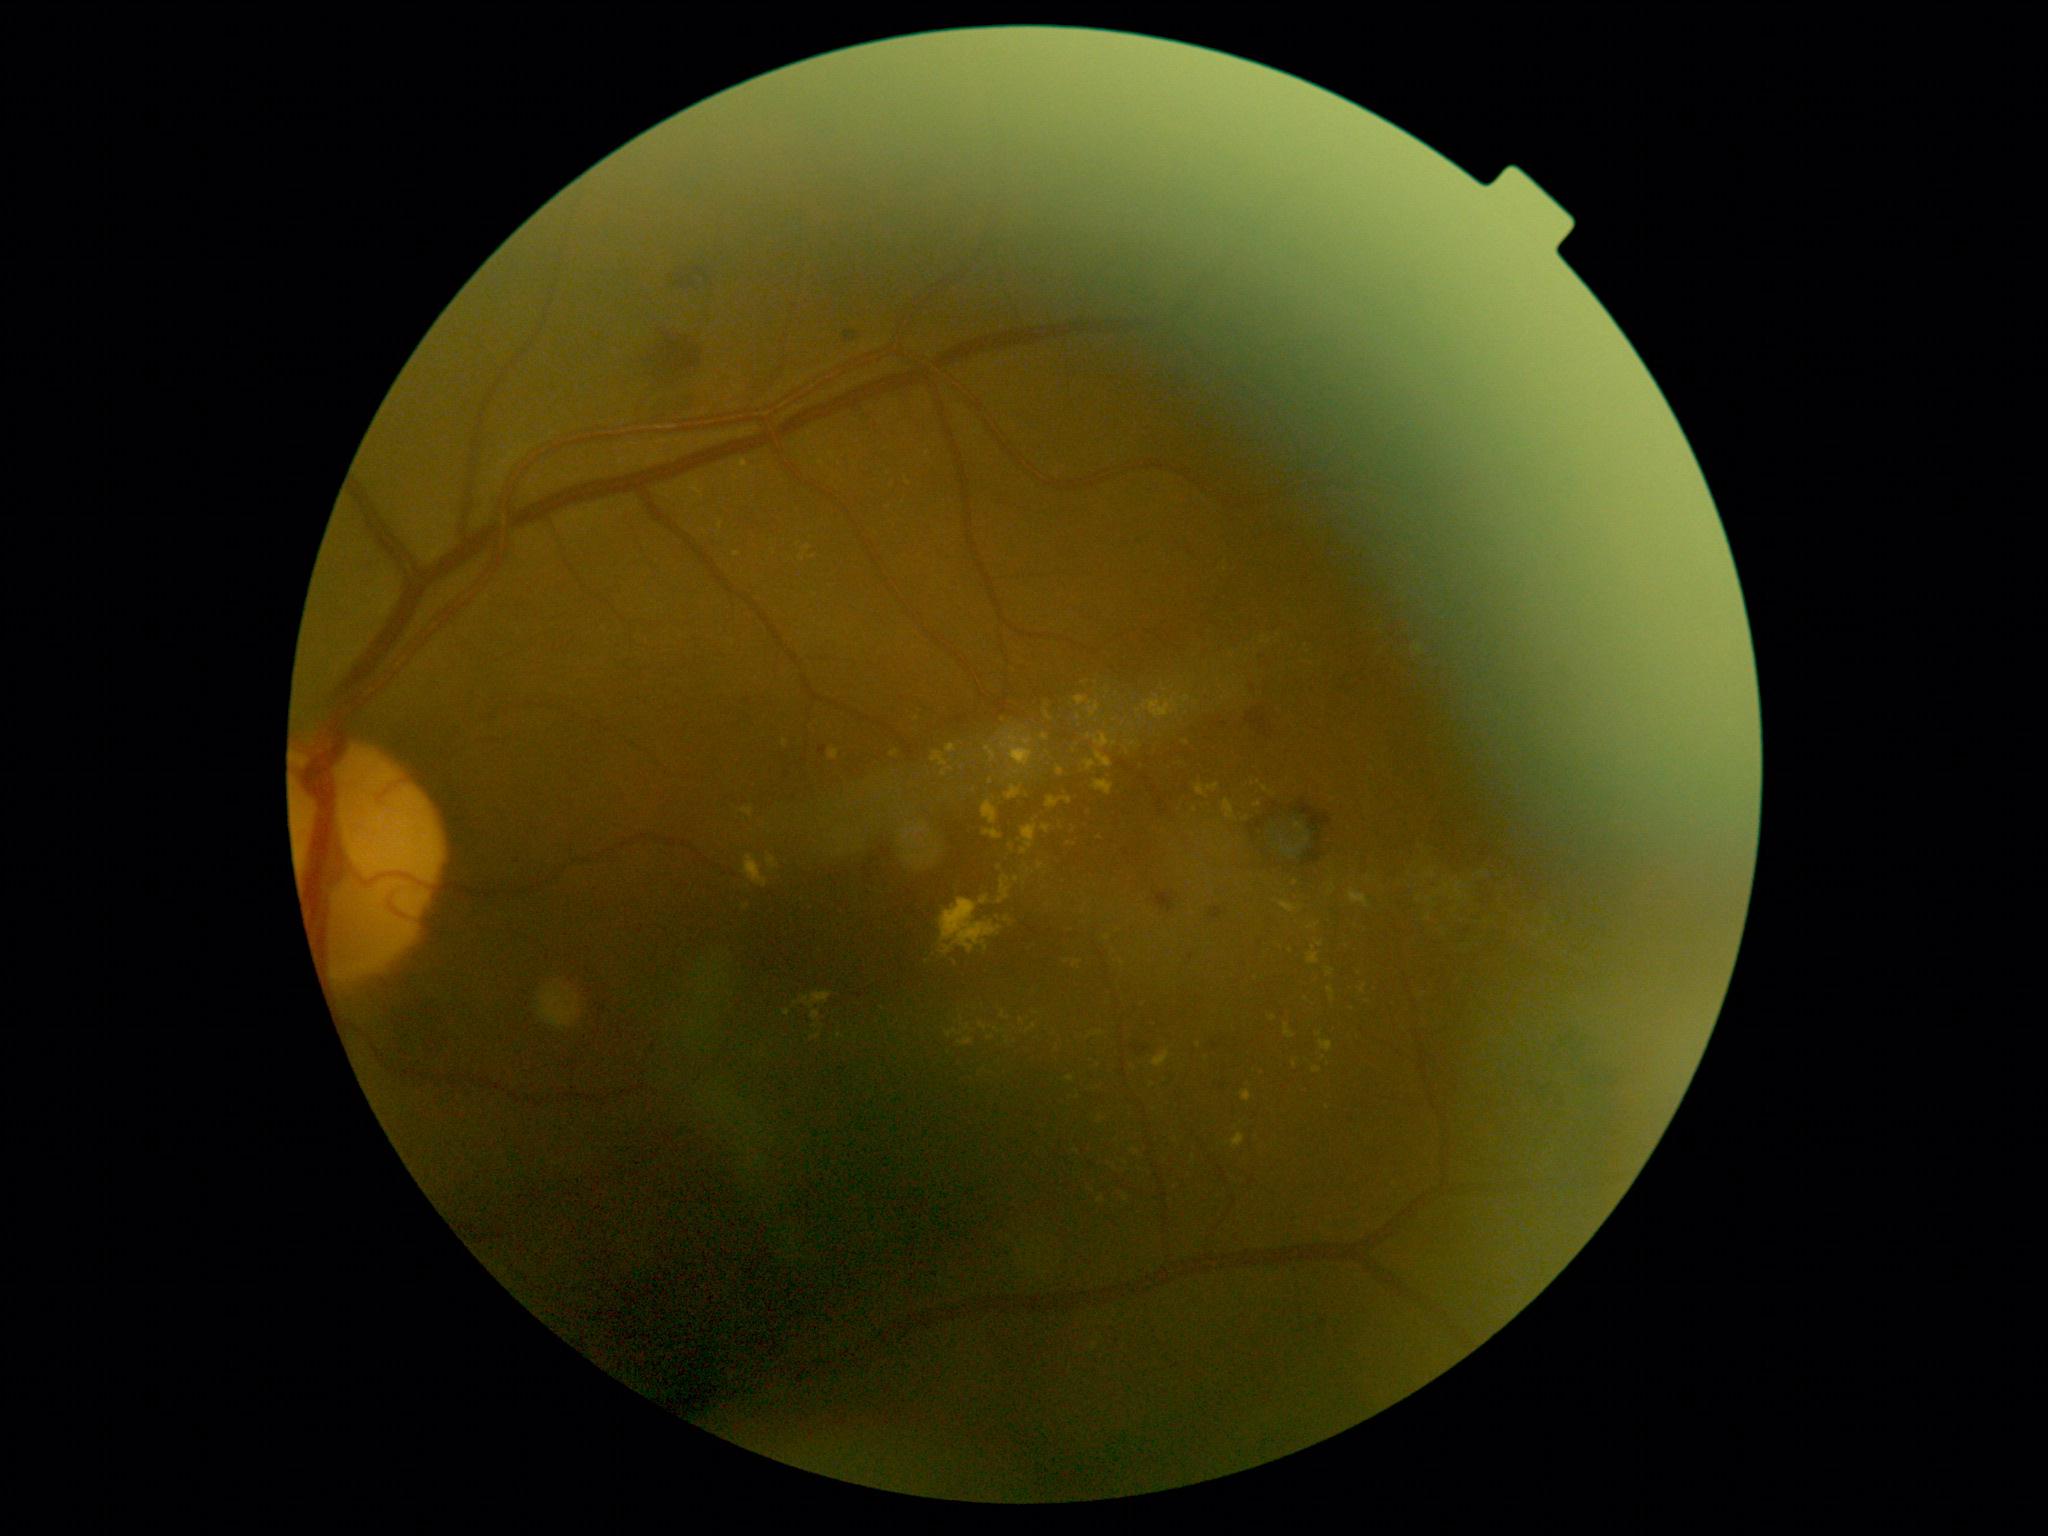
Retinopathy: grade 2.
Hemorrhages found at {"x1": 1302, "y1": 846, "x2": 1326, "y2": 868}, {"x1": 1209, "y1": 907, "x2": 1225, "y2": 920}, {"x1": 1151, "y1": 892, "x2": 1176, "y2": 914}, {"x1": 1248, "y1": 820, "x2": 1265, "y2": 839}, {"x1": 1218, "y1": 1084, "x2": 1231, "y2": 1091}, {"x1": 1290, "y1": 800, "x2": 1333, "y2": 833}, {"x1": 1245, "y1": 709, "x2": 1274, "y2": 739}, {"x1": 1316, "y1": 833, "x2": 1322, "y2": 842}, {"x1": 841, "y1": 329, "x2": 856, "y2": 341}, {"x1": 643, "y1": 331, "x2": 691, "y2": 380}, {"x1": 670, "y1": 264, "x2": 704, "y2": 289}, {"x1": 1131, "y1": 1046, "x2": 1148, "y2": 1055}.
Small hemorrhages approximately at pt(1215, 1046).
Microaneurysms found at {"x1": 818, "y1": 746, "x2": 827, "y2": 756}.
Small microaneurysms approximately at pt(1215, 725), pt(1191, 958), pt(1127, 853), pt(1253, 688).
Hard exudates are present, including at {"x1": 1000, "y1": 1011, "x2": 1011, "y2": 1020}, {"x1": 783, "y1": 740, "x2": 788, "y2": 748}, {"x1": 958, "y1": 1037, "x2": 974, "y2": 1046}, {"x1": 987, "y1": 1036, "x2": 995, "y2": 1040}, {"x1": 1057, "y1": 767, "x2": 1064, "y2": 777}, {"x1": 1280, "y1": 901, "x2": 1302, "y2": 914}, {"x1": 1090, "y1": 1031, "x2": 1105, "y2": 1037}, {"x1": 1313, "y1": 1068, "x2": 1322, "y2": 1074}, {"x1": 1319, "y1": 1040, "x2": 1334, "y2": 1053}, {"x1": 1426, "y1": 914, "x2": 1432, "y2": 922}, {"x1": 938, "y1": 898, "x2": 1002, "y2": 956}, {"x1": 1021, "y1": 825, "x2": 1038, "y2": 855}.
Small hard exudates approximately at pt(1418, 900), pt(1127, 753), pt(1482, 874), pt(1126, 1198), pt(1152, 1086), pt(1008, 1043).
No soft exudates identified.